Color fundus image; image size 1659x2212; acquired with a Remidio smartphone fundus camera:
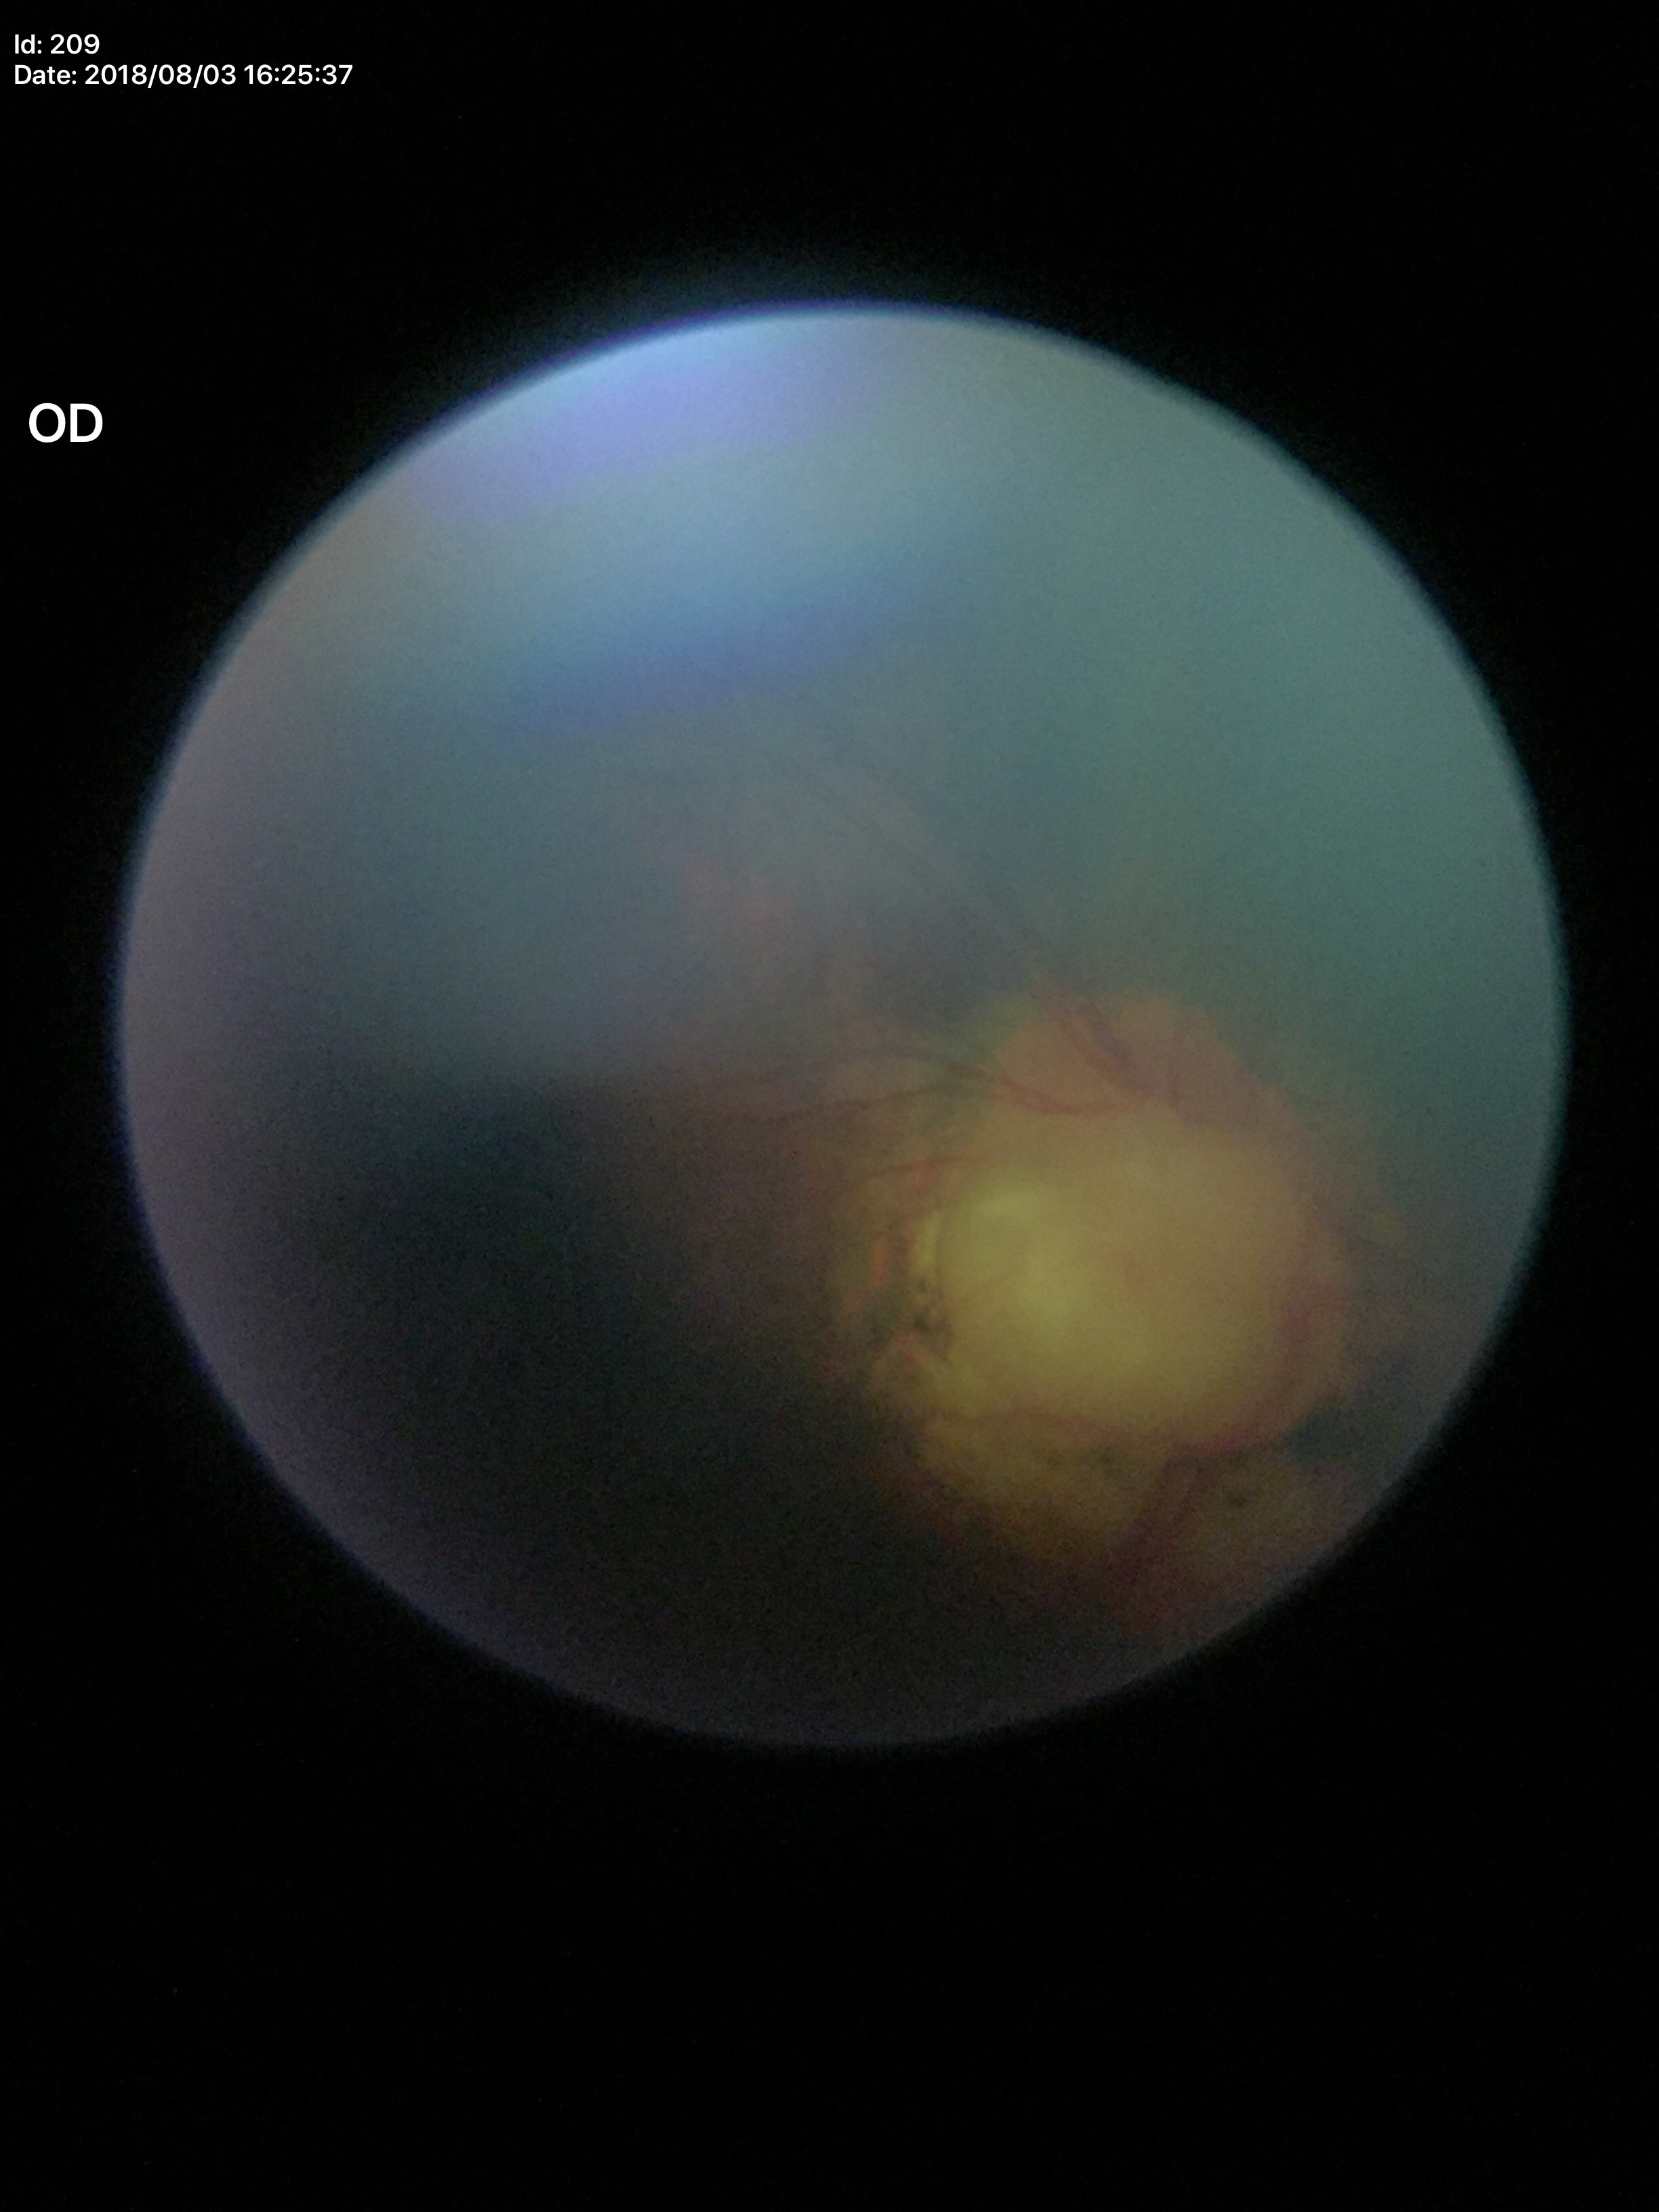 Annotations:
- vertical cup-to-disc ratio (VCDR): 0.72
- Glaucoma screening: suspicious findings (4/5 graders called glaucoma suspect)